Acquired with a NIDEK AFC-230. Graded on the modified Davis scale. Without pupil dilation. 848 x 848 pixels. Color fundus image: 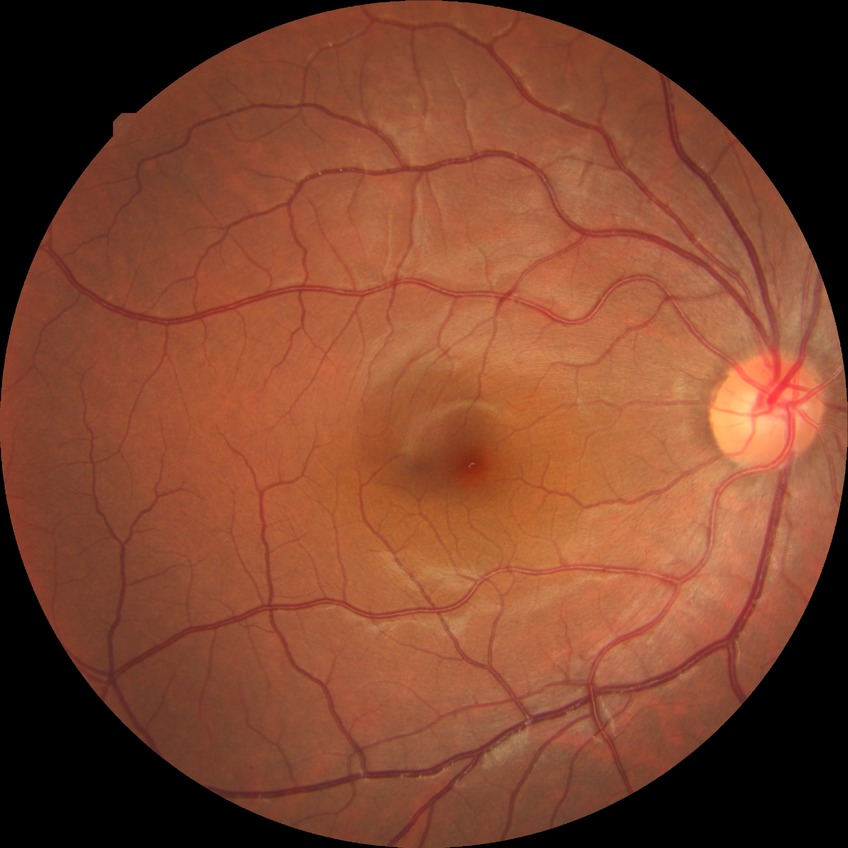 • diabetic retinopathy (DR) — NDR (no diabetic retinopathy)